Nonmydriatic, posterior pole photograph
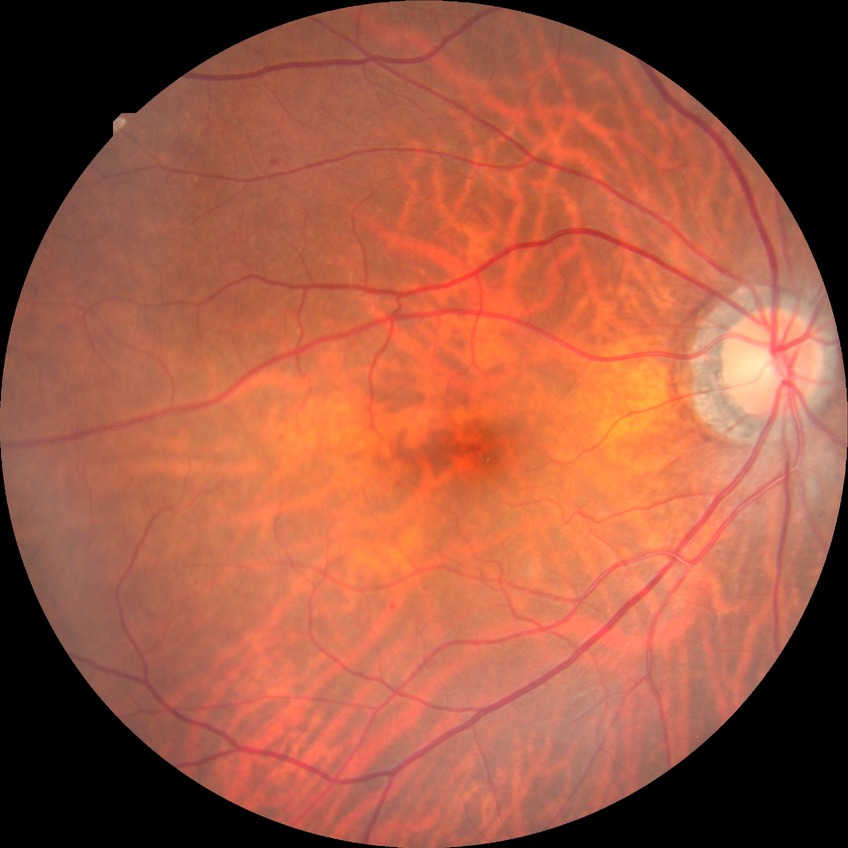   proliferative_class: non-proliferative diabetic retinopathy
  davis_grade: simple diabetic retinopathy